Infant wide-field fundus photograph — 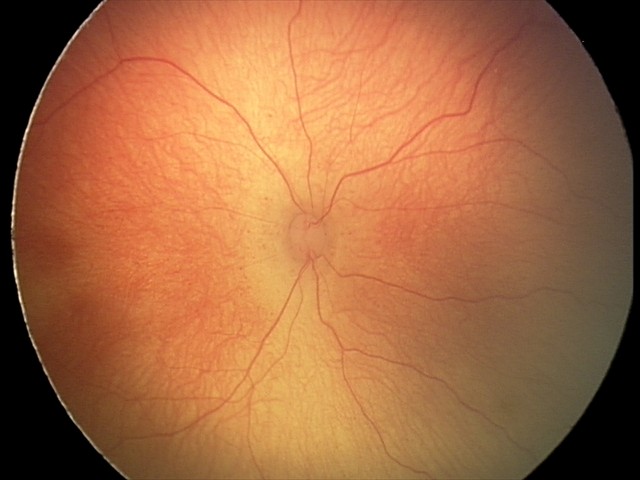
Without plus disease.
From an examination with diagnosis of retinopathy of prematurity (ROP) stage 2.